2212 x 1659 pixels, 45° field of view, retinal fundus photograph
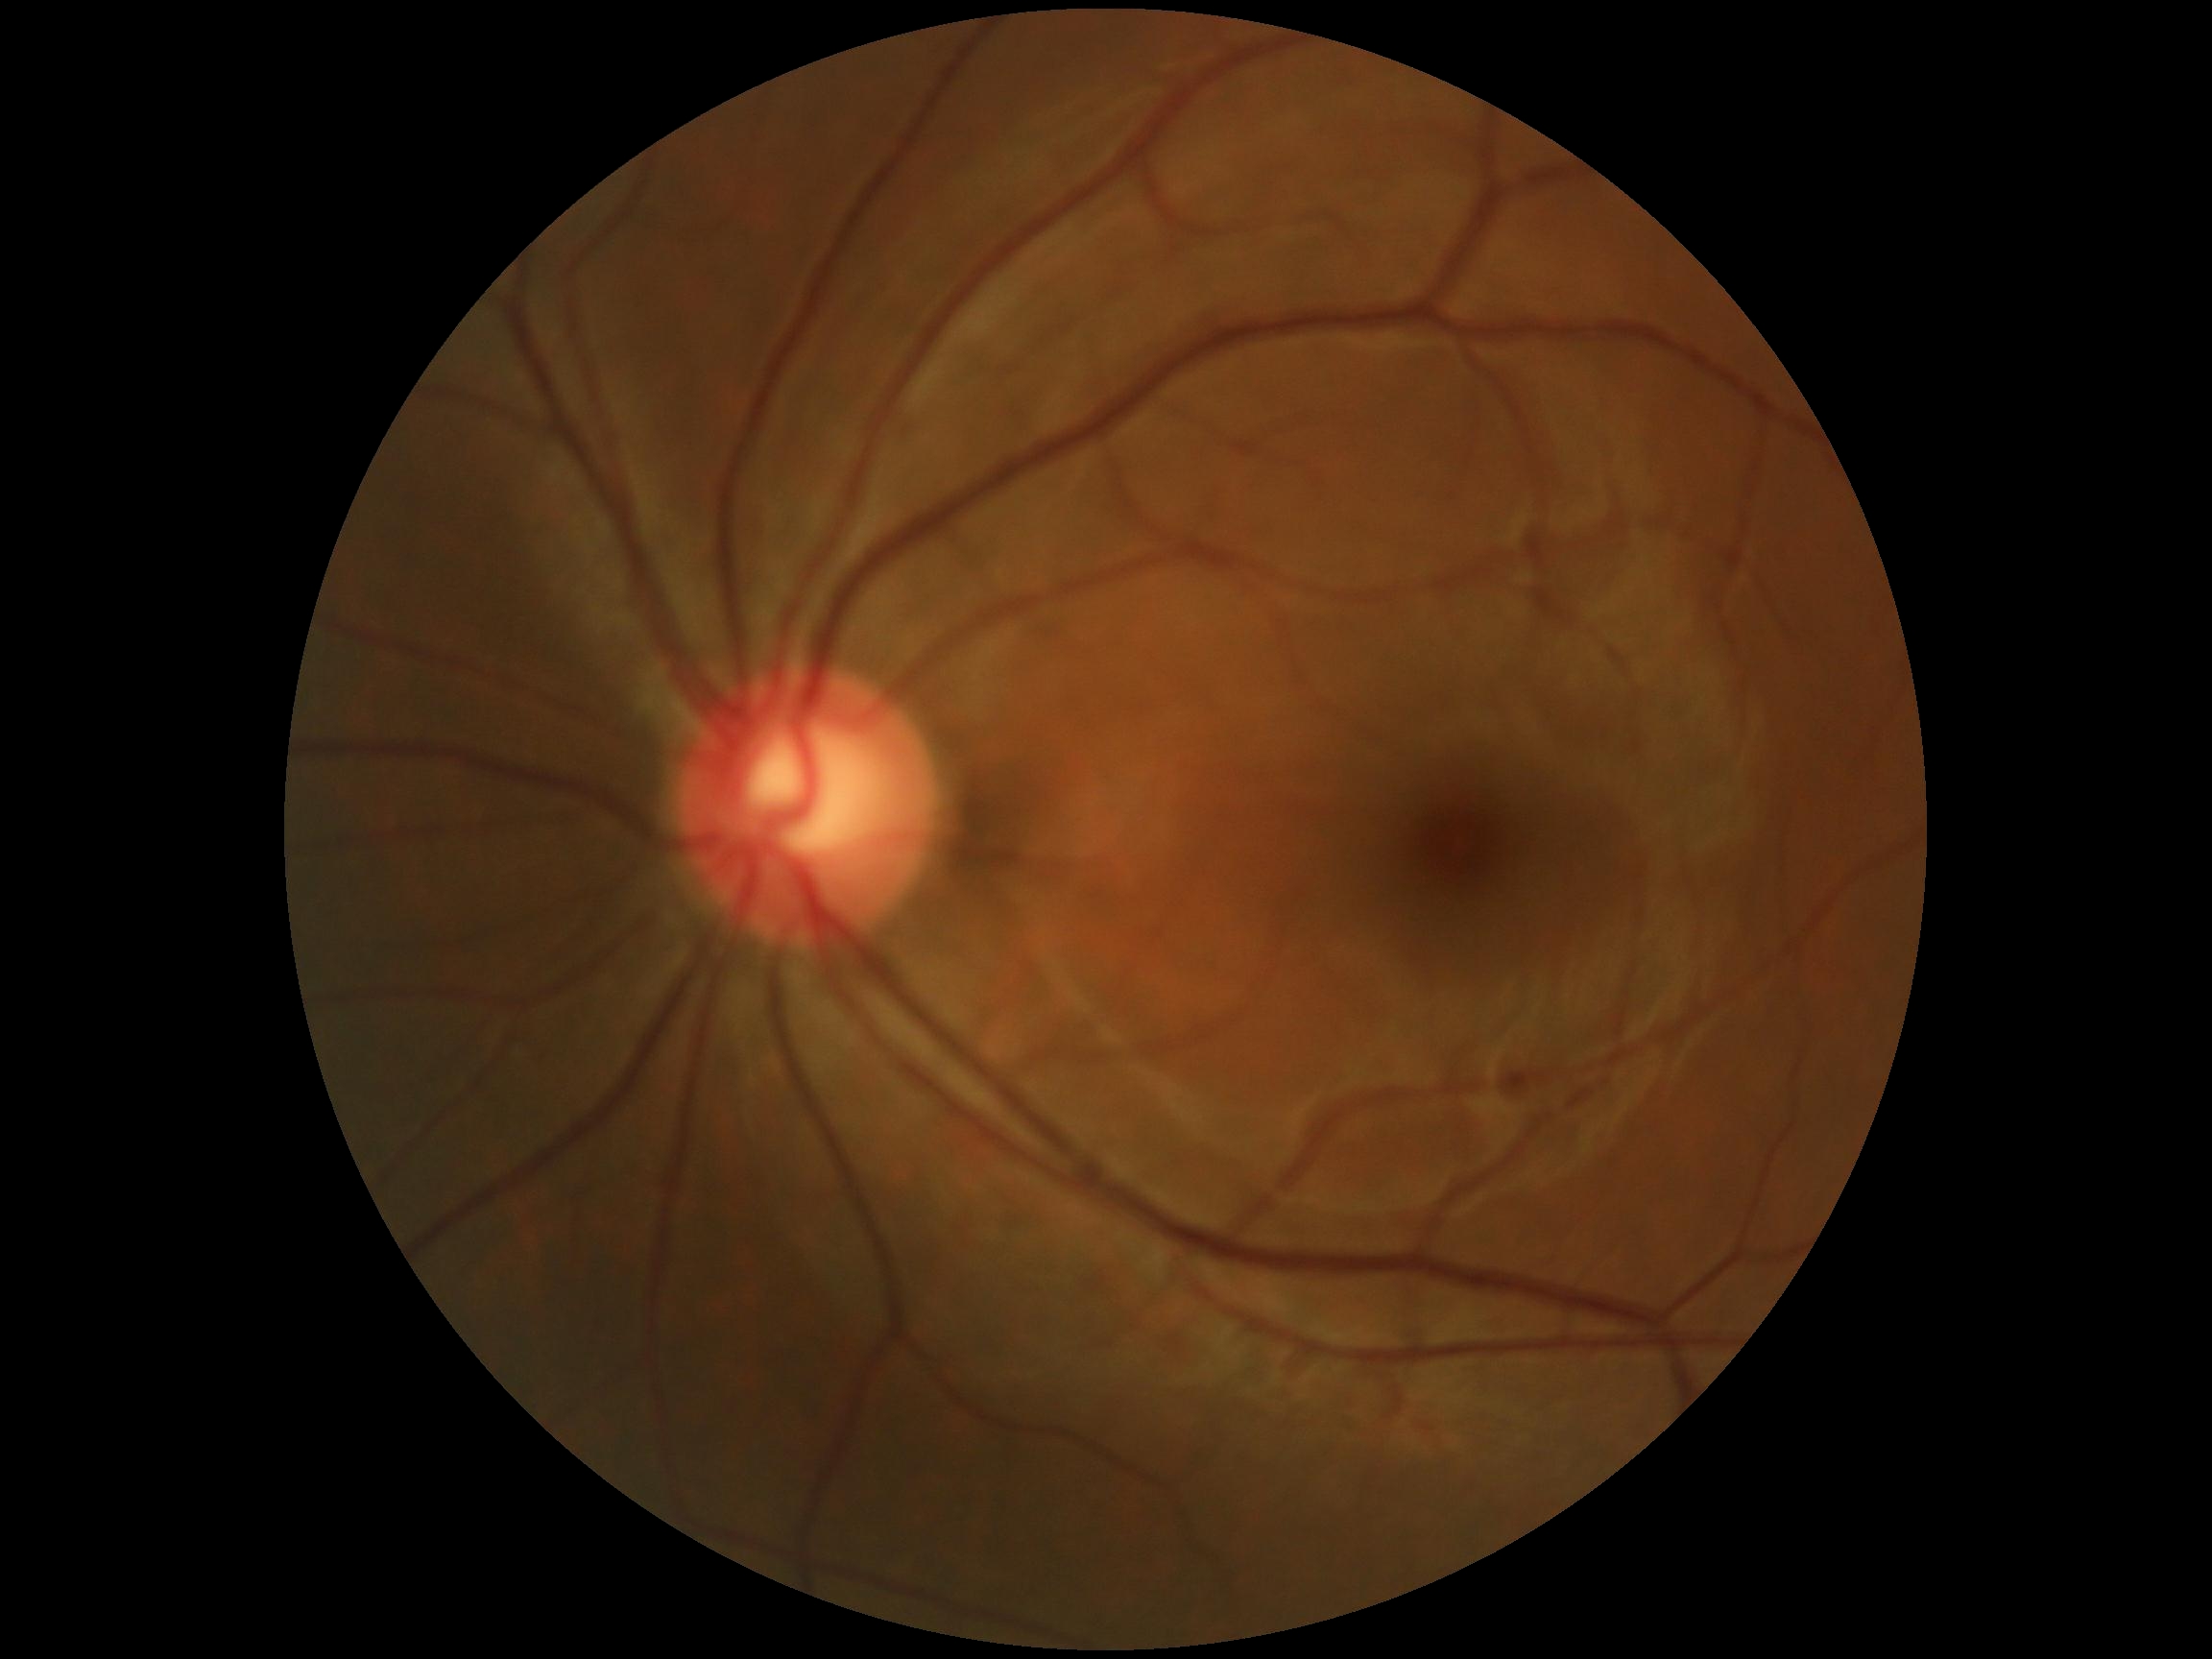 * diabetic retinopathy (DR) — 0
* DR impression — no apparent DR